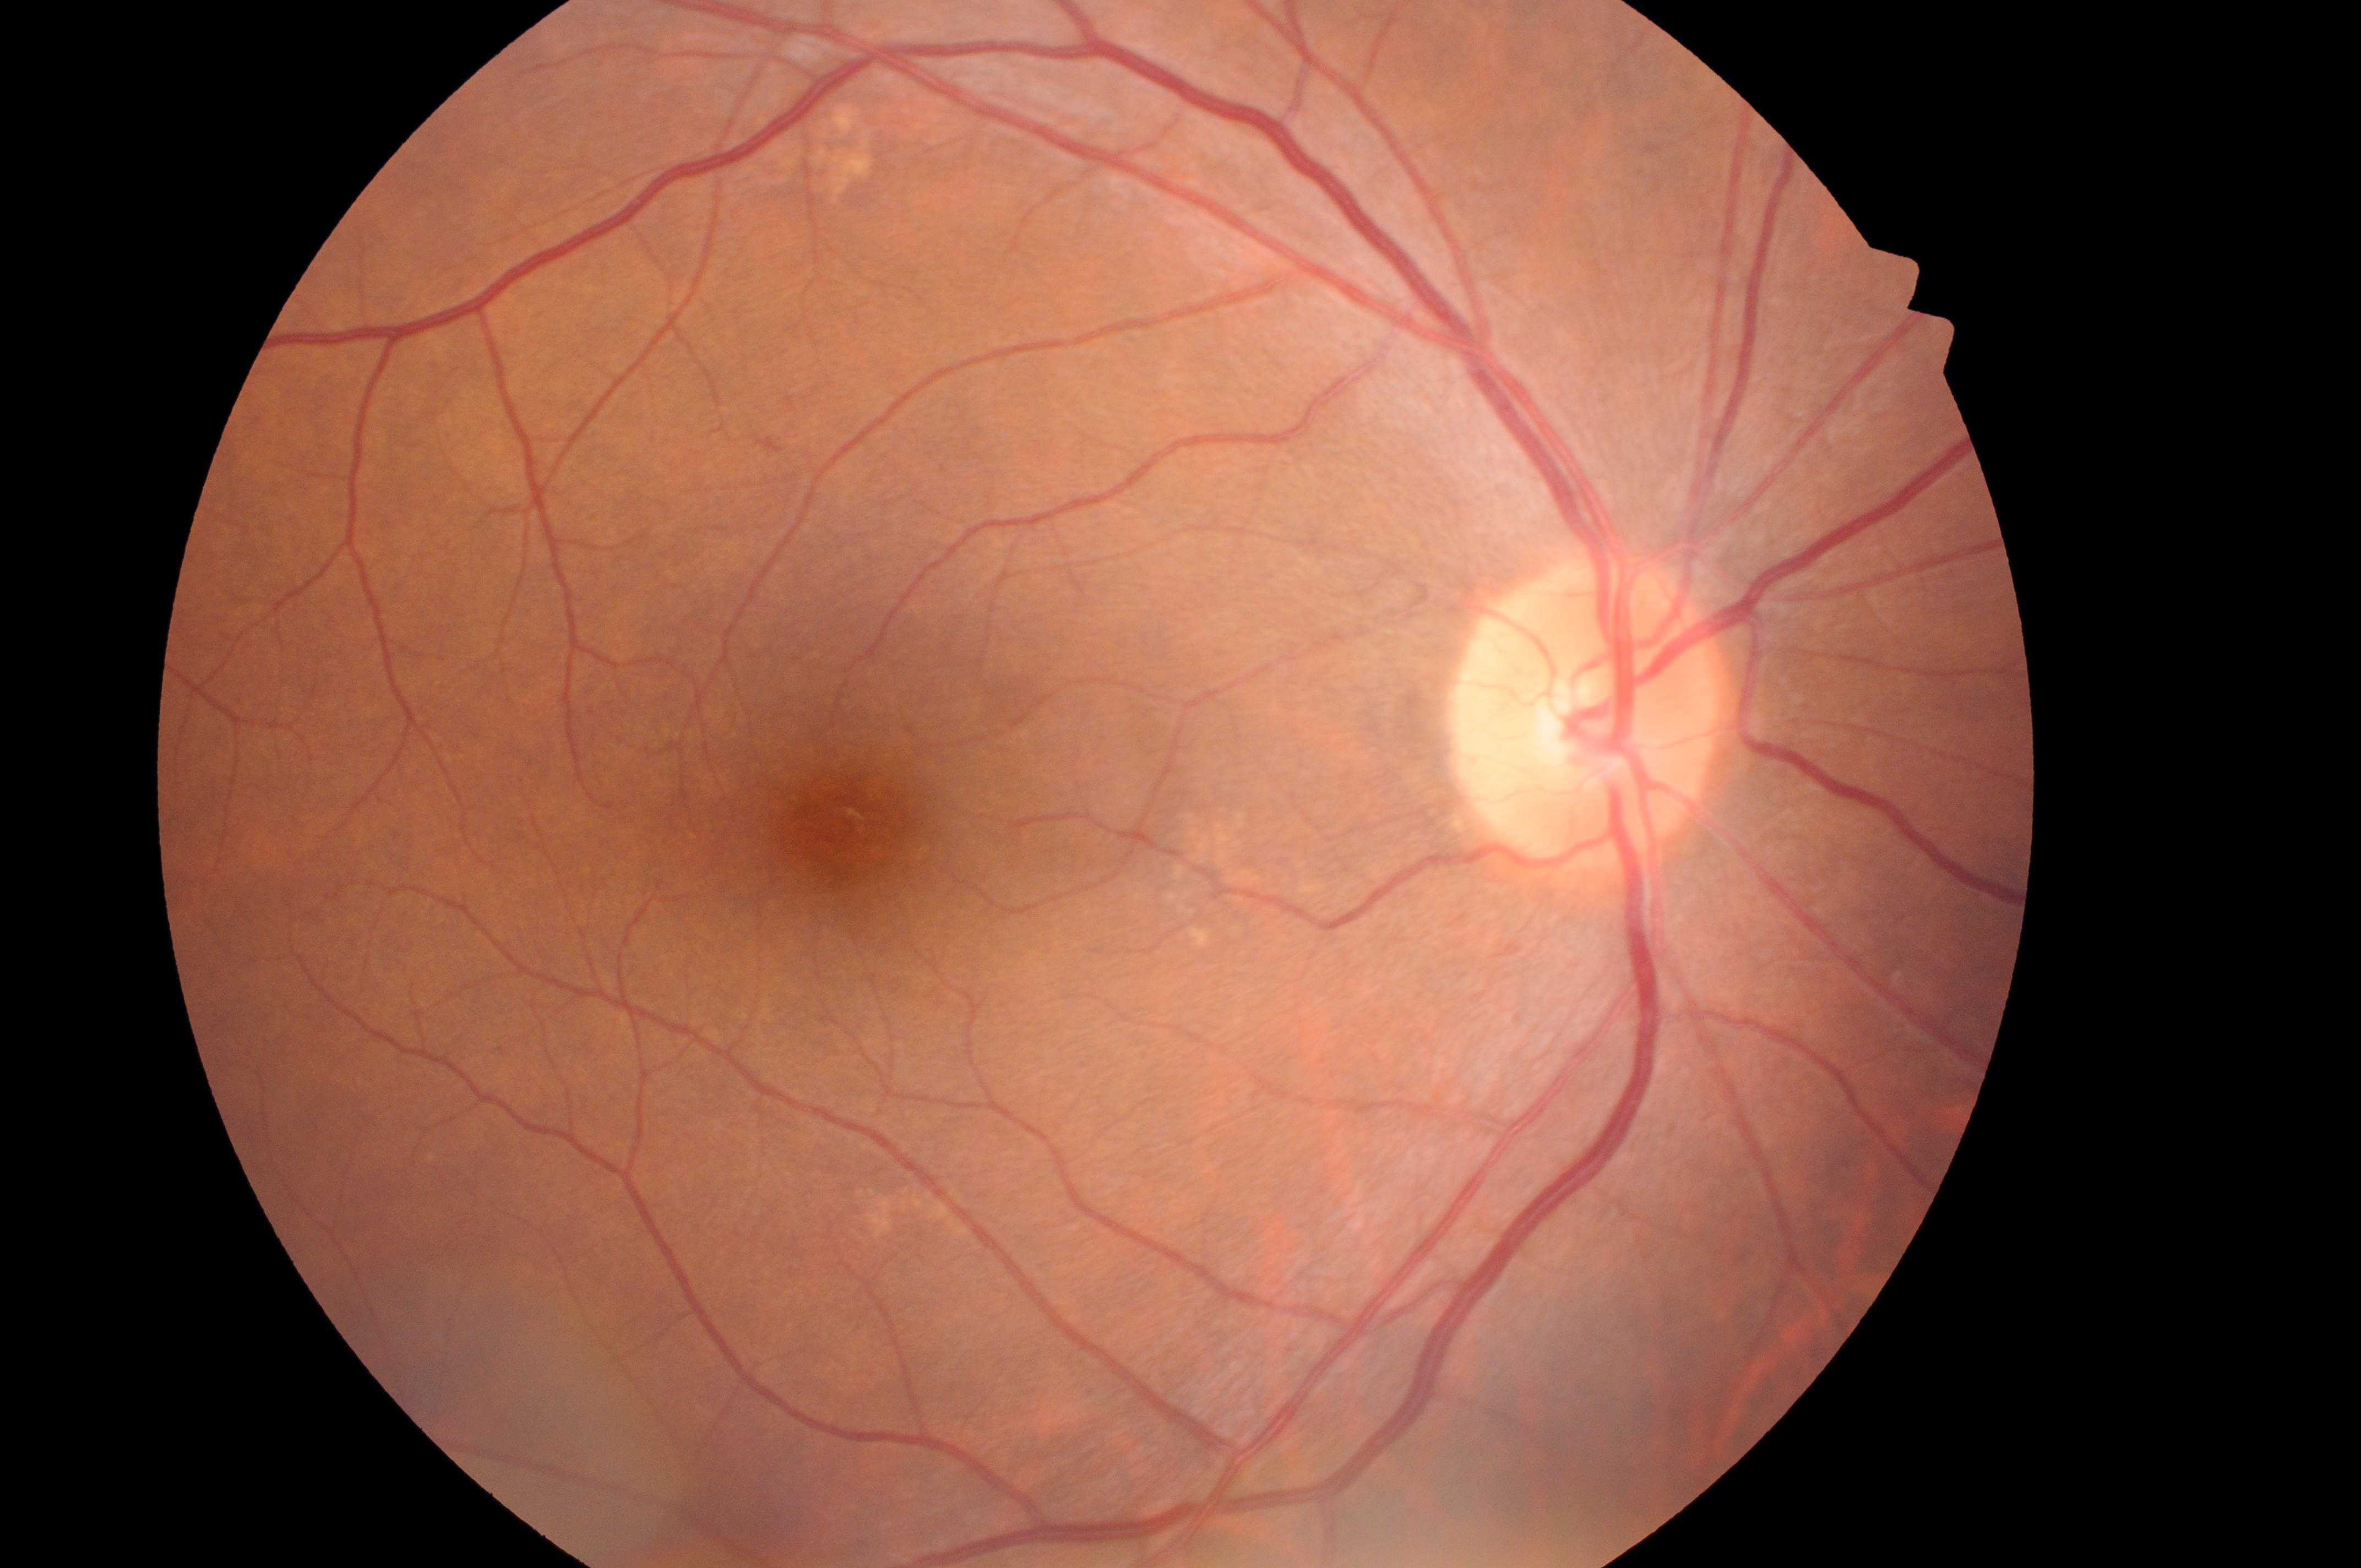

The foveal center is at (846, 829).
The image shows the right eye.
DR stage is grade 0 (no apparent retinopathy).
The optic disc is at (1582, 727).
DME risk is grade 0 (no risk).